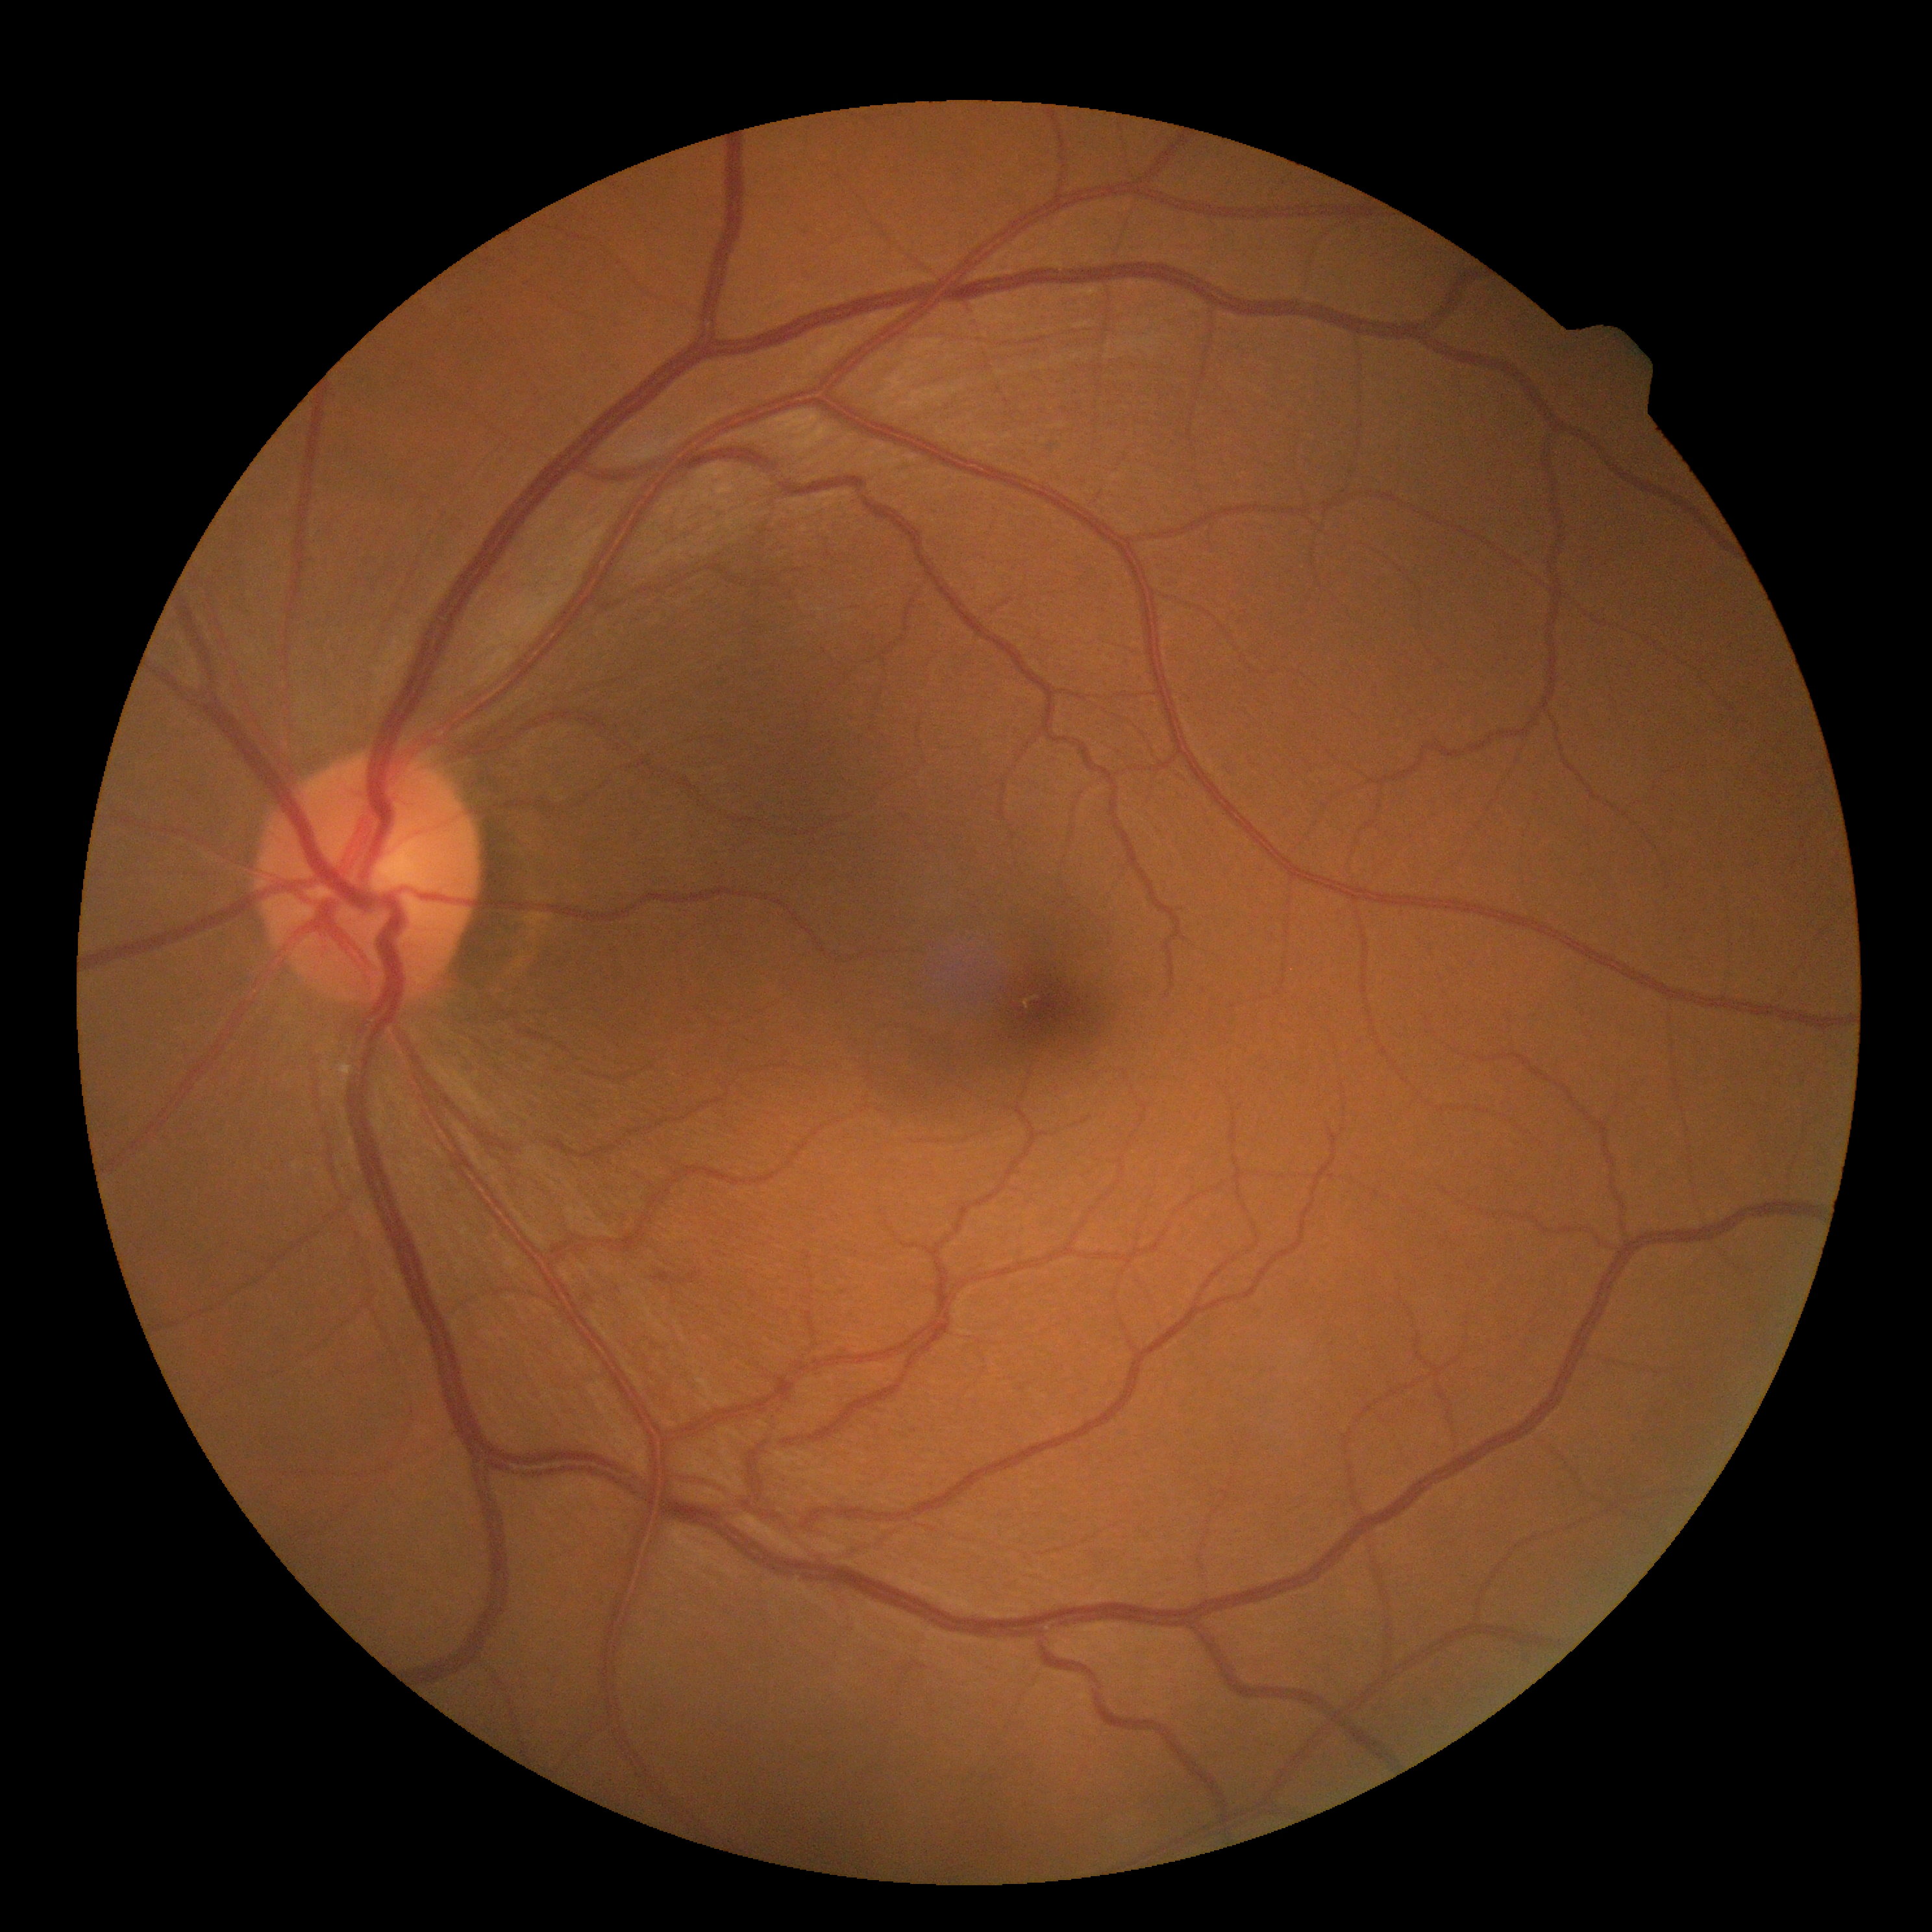

DR: 0. No signs of diabetic retinopathy.